45° FOV, color fundus image — 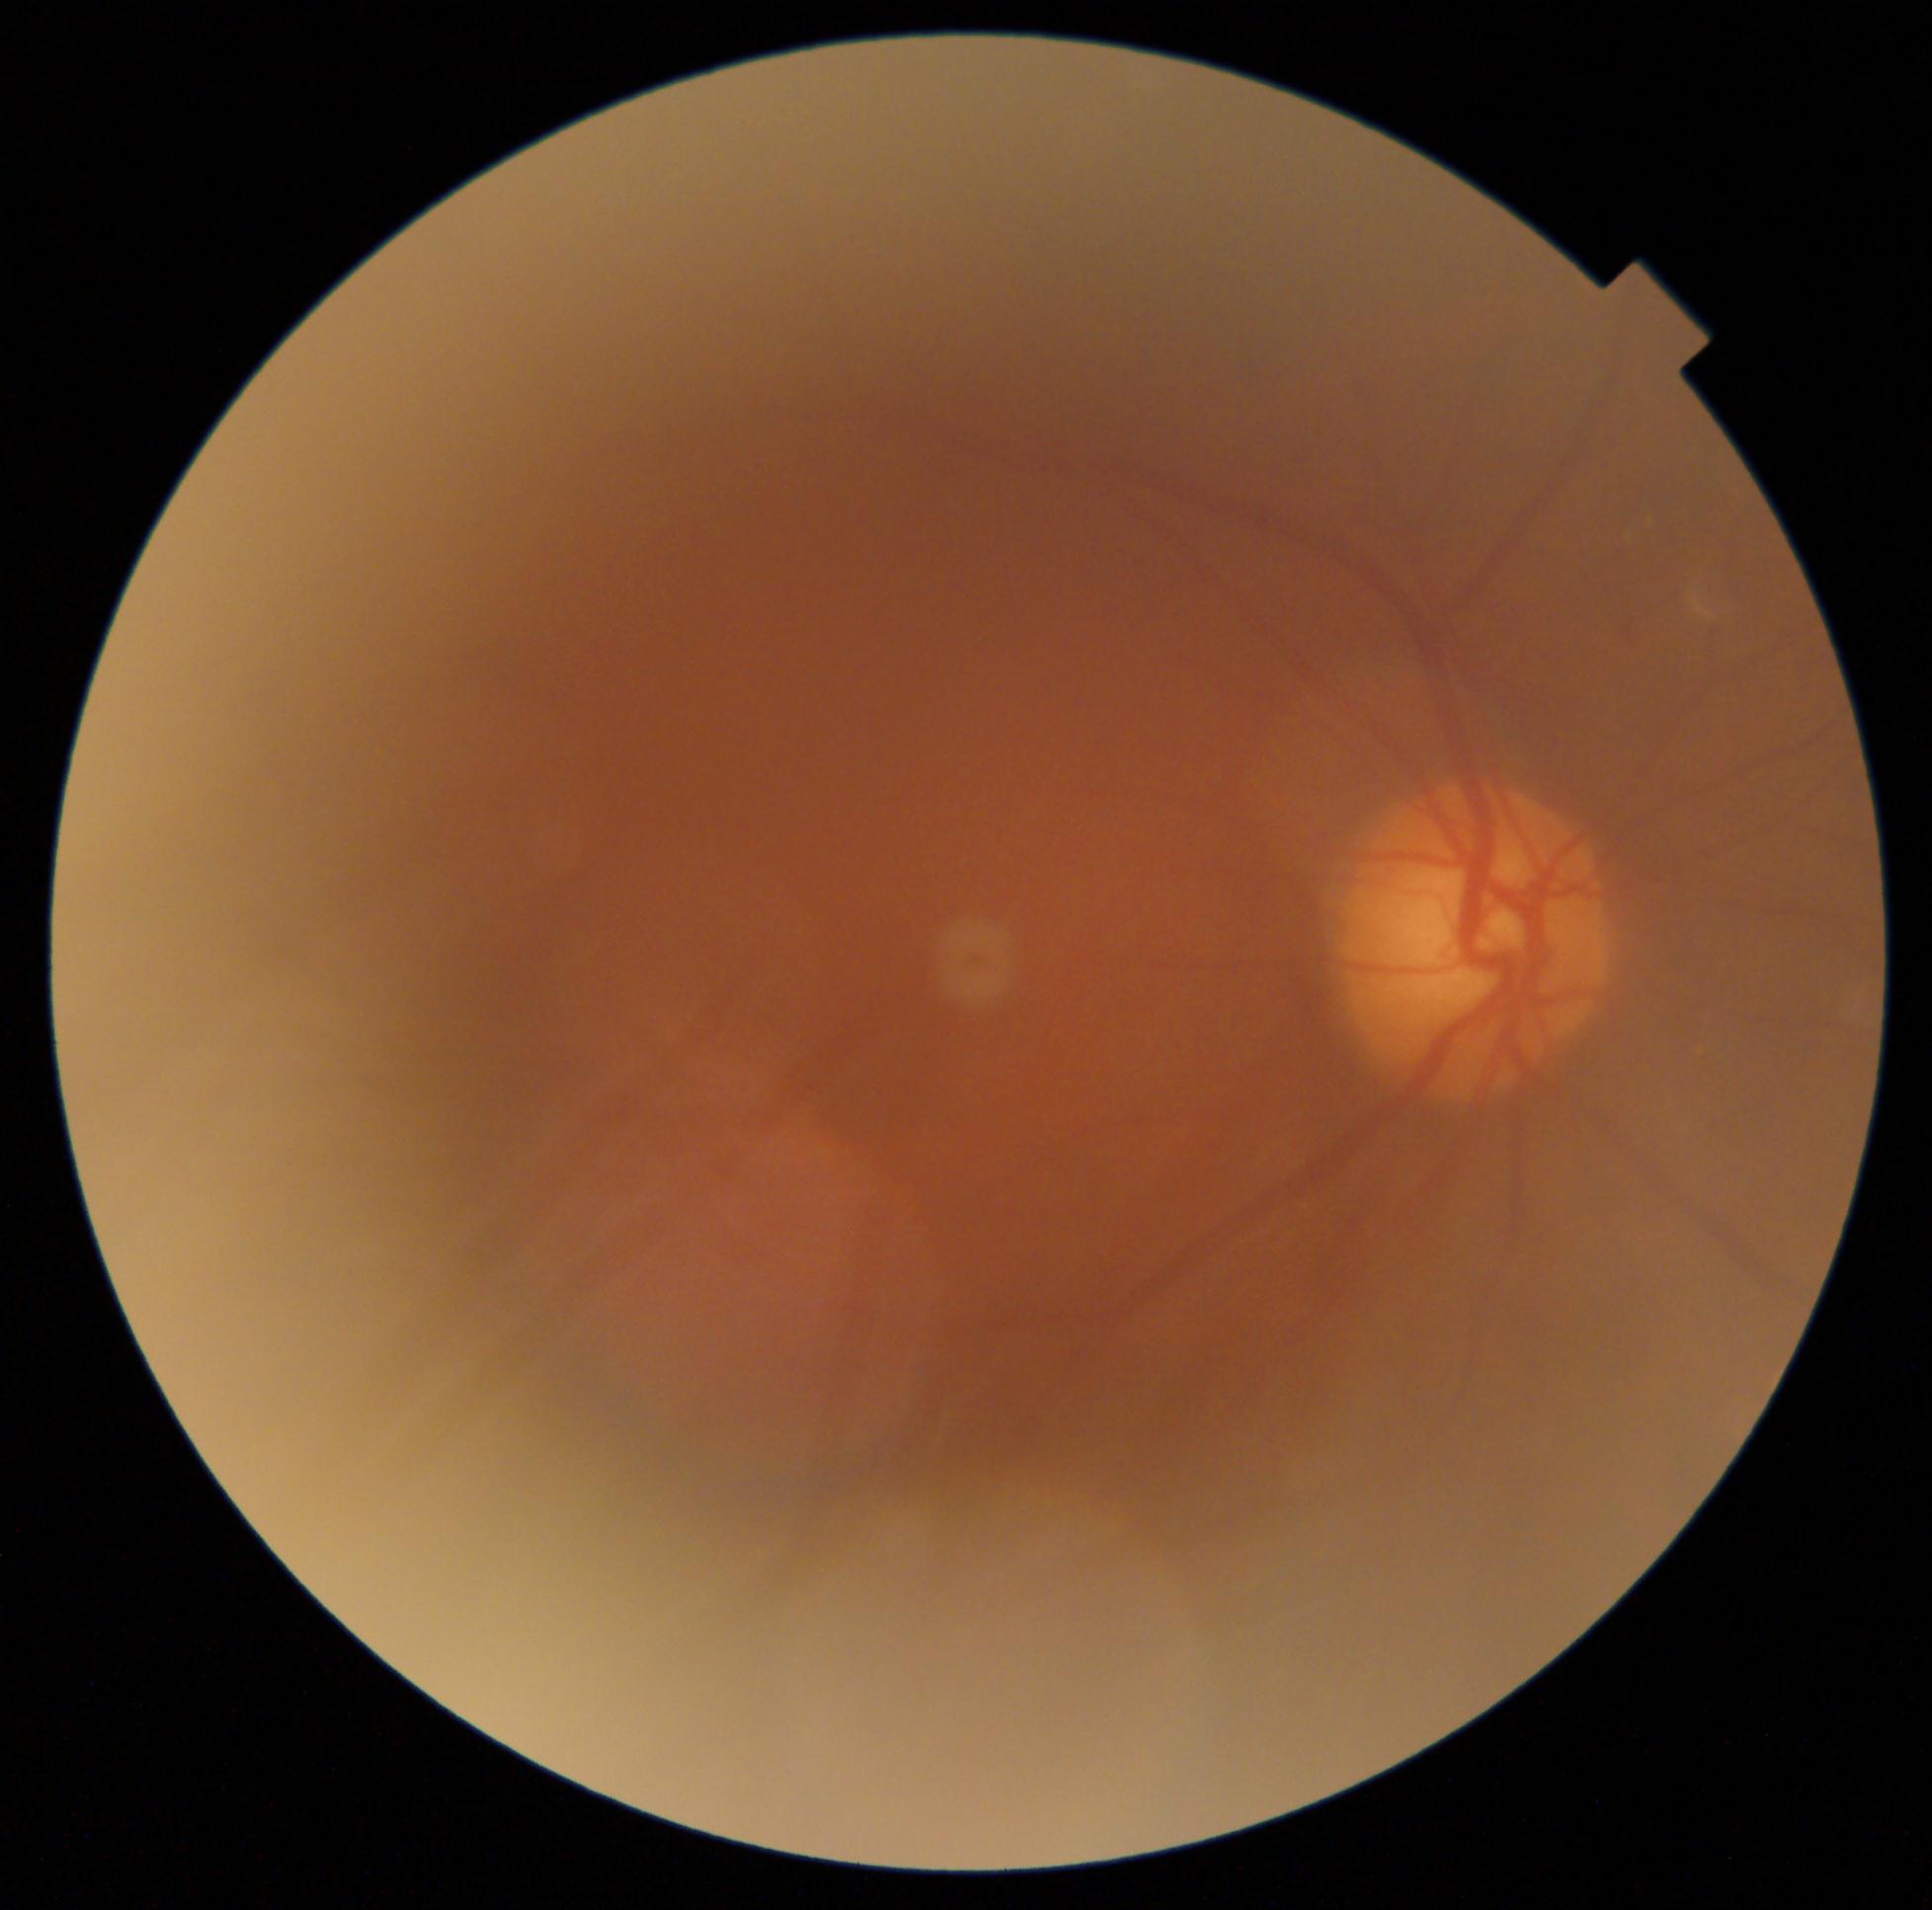

DR grade: 2 (moderate NPDR).